NIDEK AFC-230 fundus camera; modified Davis classification: 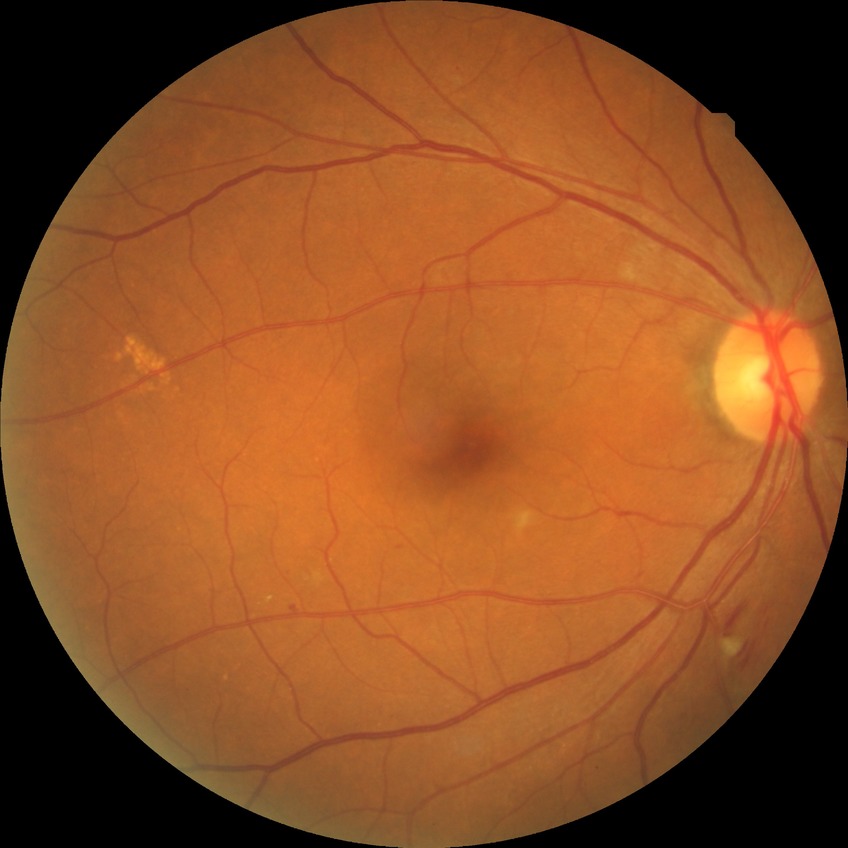 Diabetic retinopathy grade: simple diabetic retinopathy. The retinopathy is classified as non-proliferative diabetic retinopathy.